Fundus photo, FOV: 45 degrees, 1932x1932px
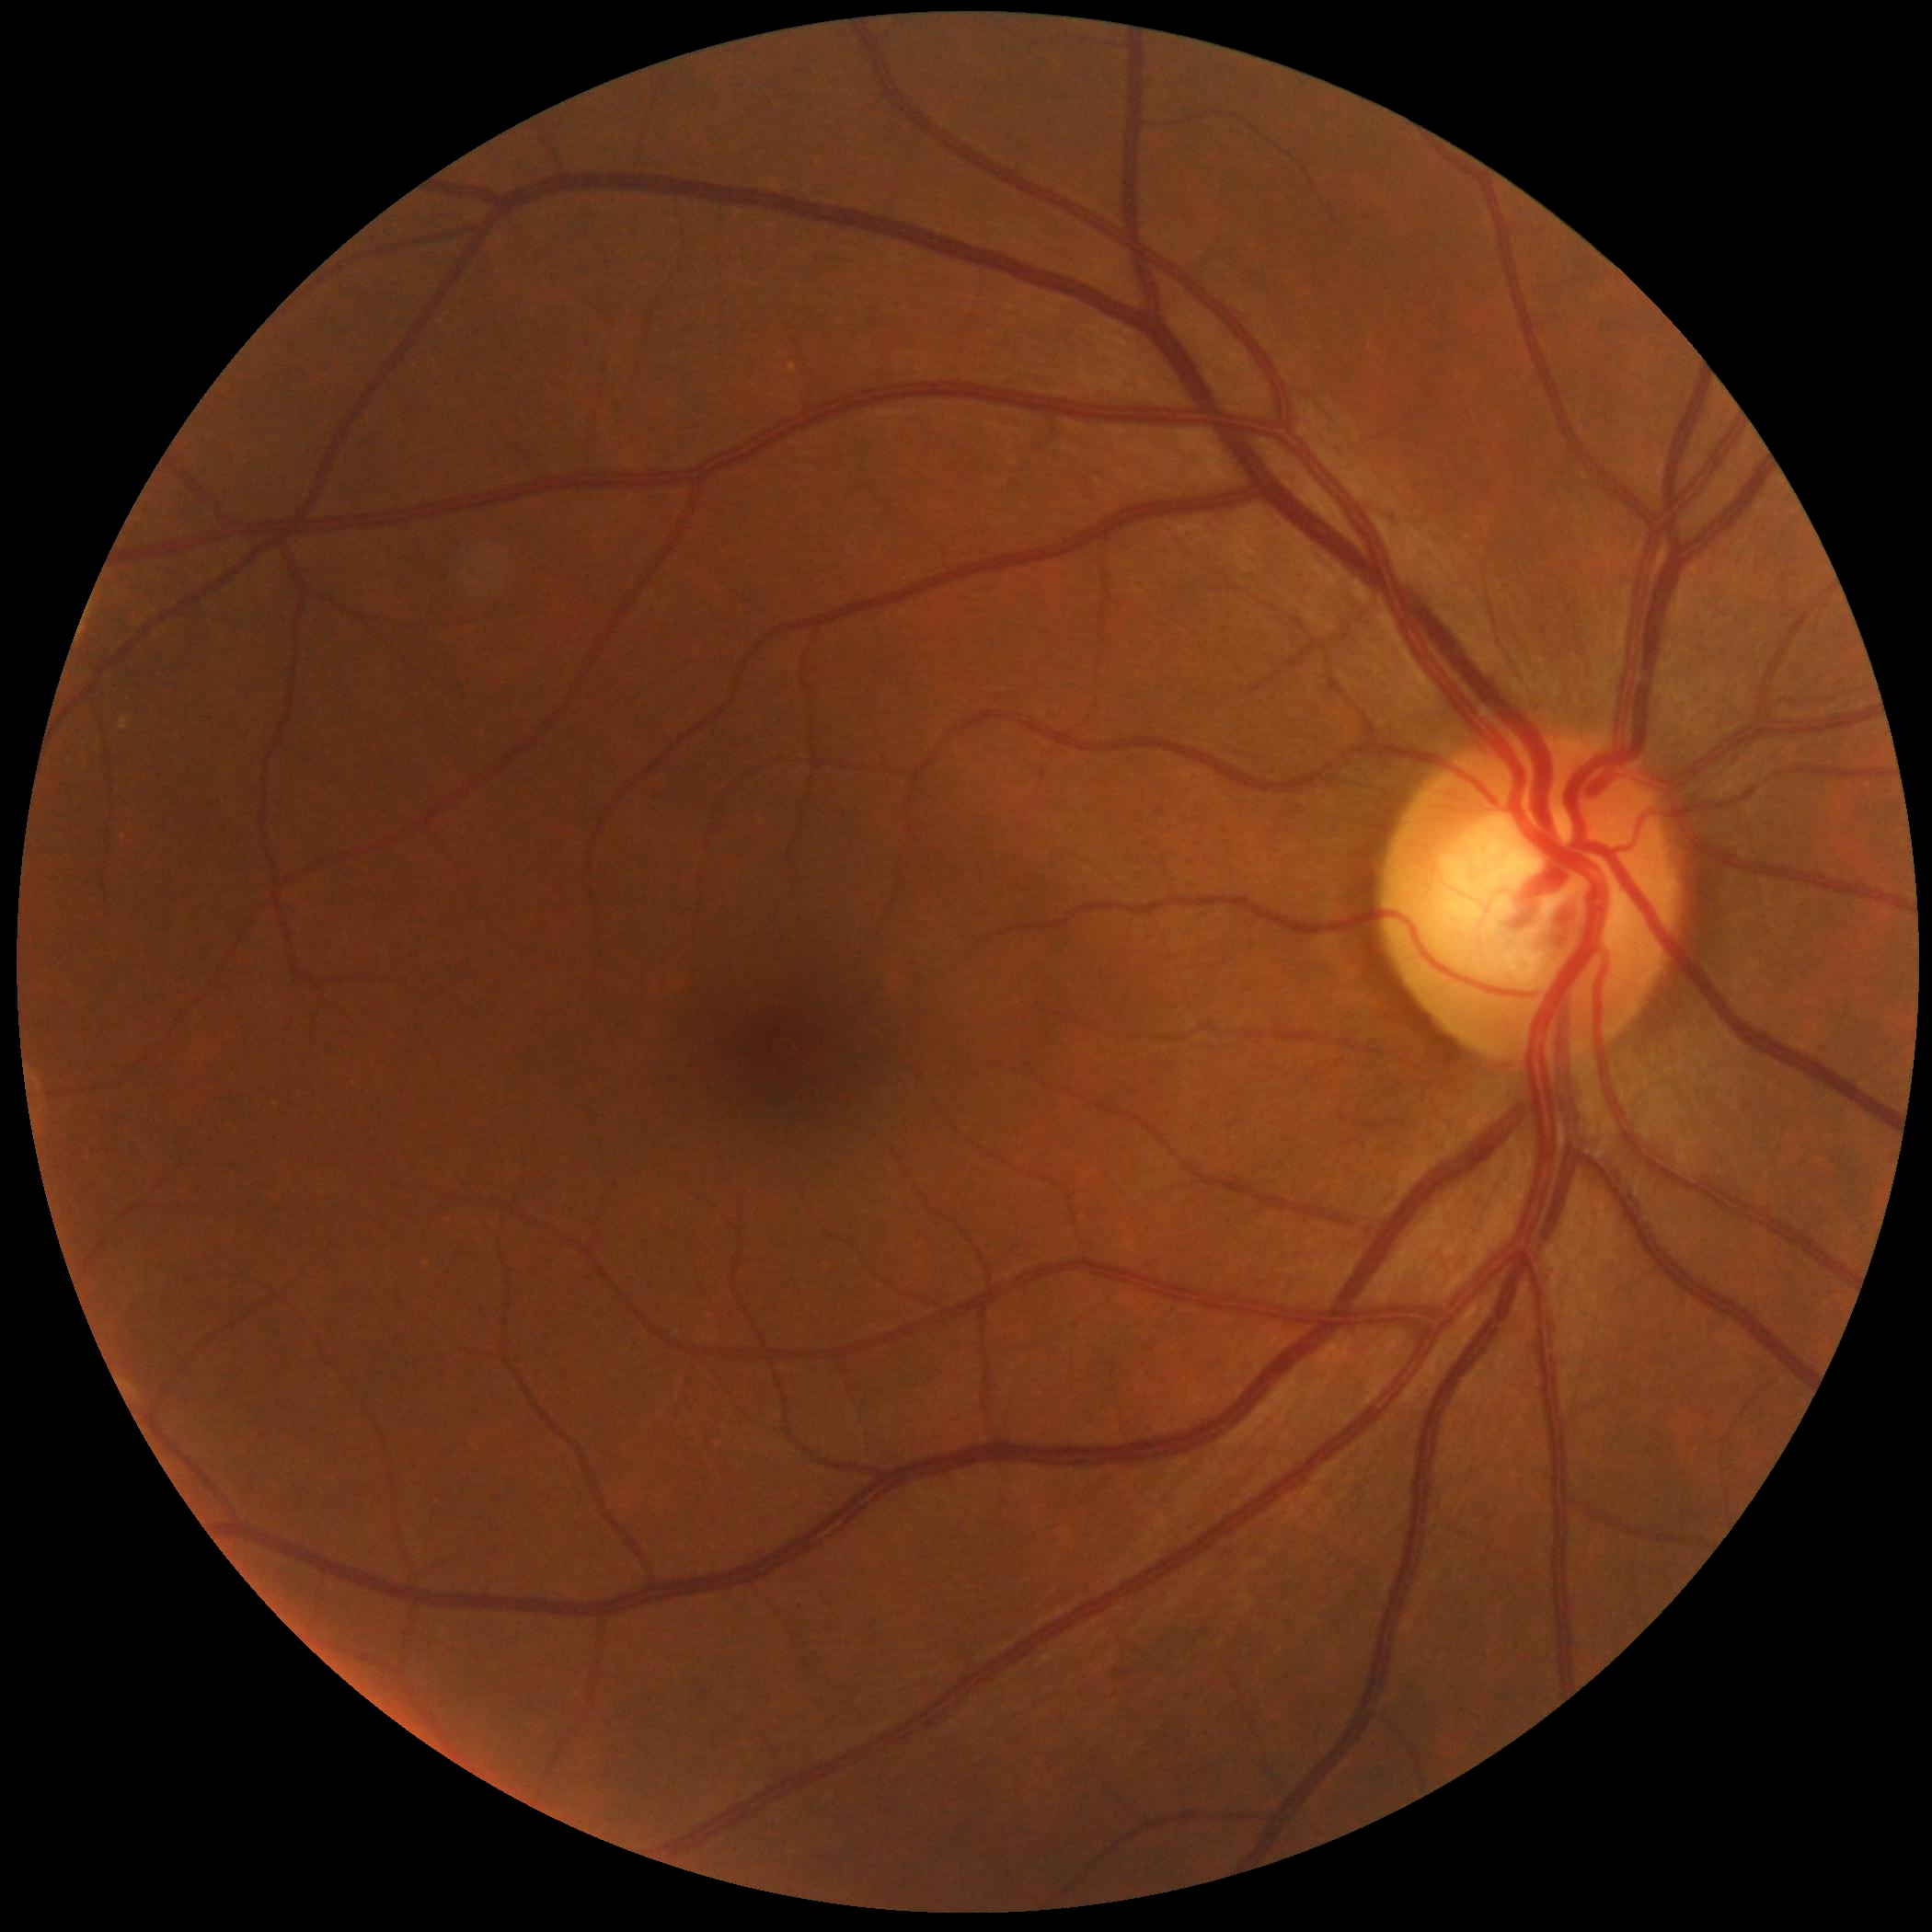

No DR findings. DR stage is grade 0.